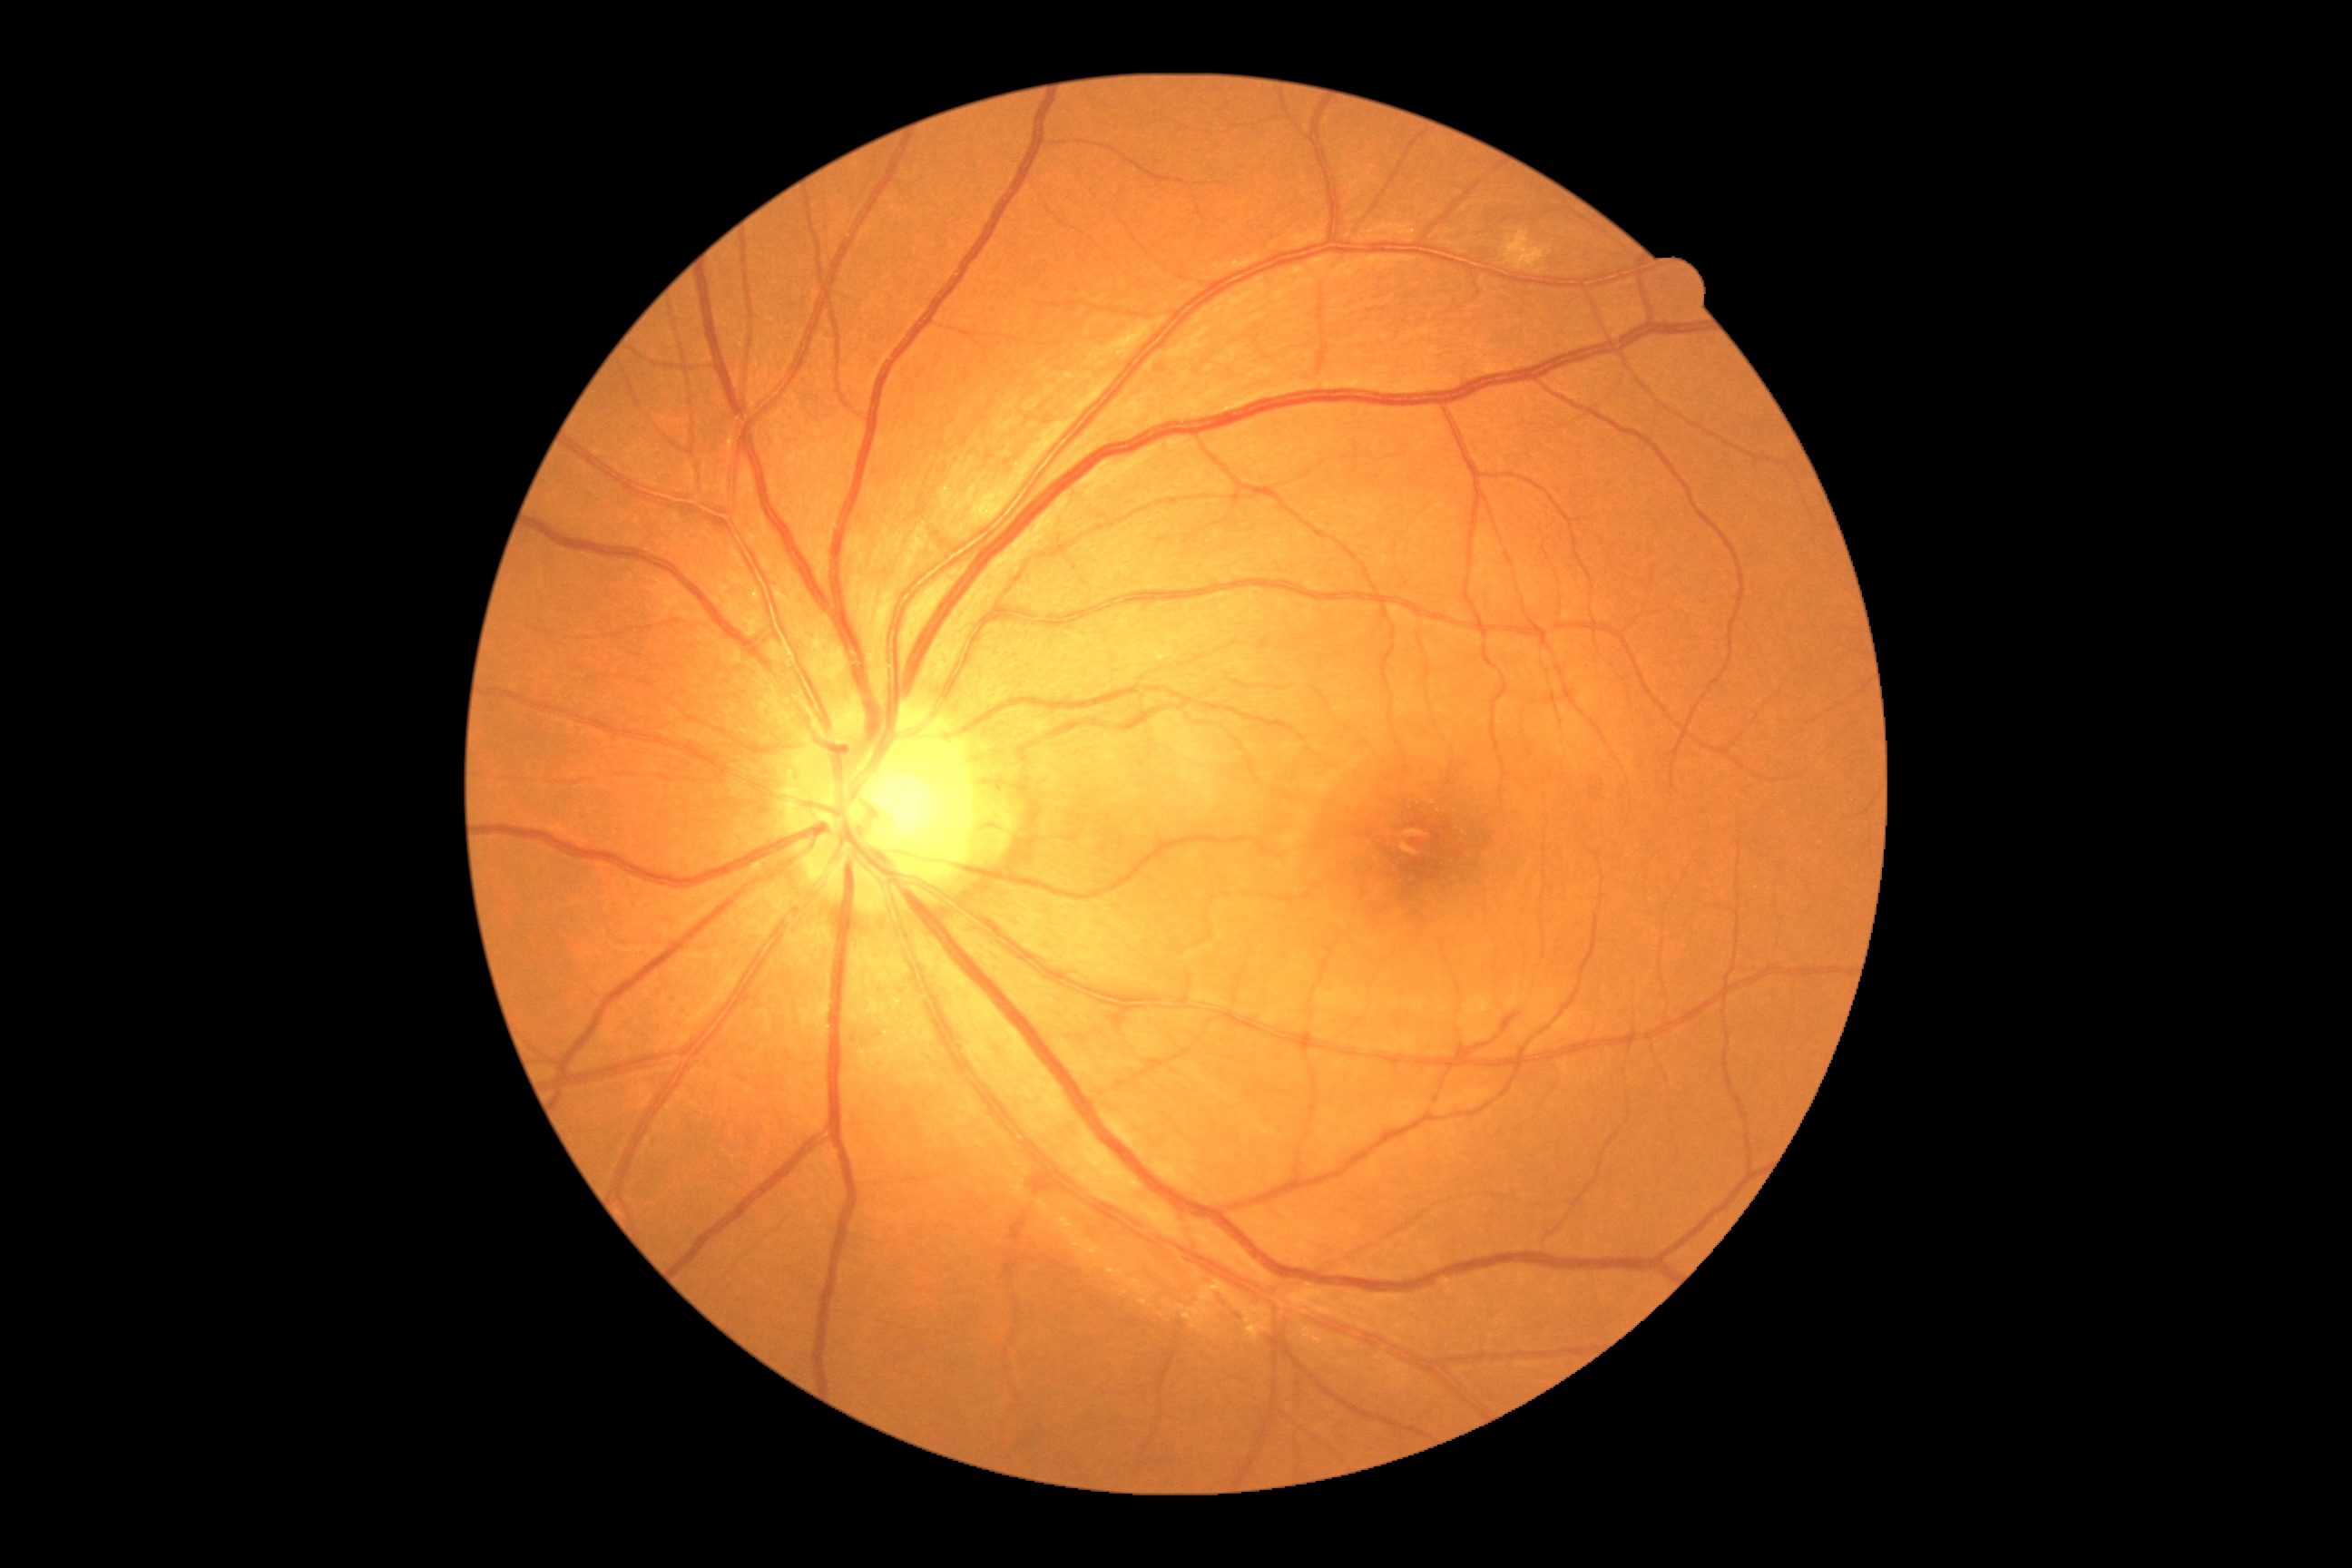 DR: no apparent retinopathy (grade 0).